848 x 848 pixels, modified Davis classification: 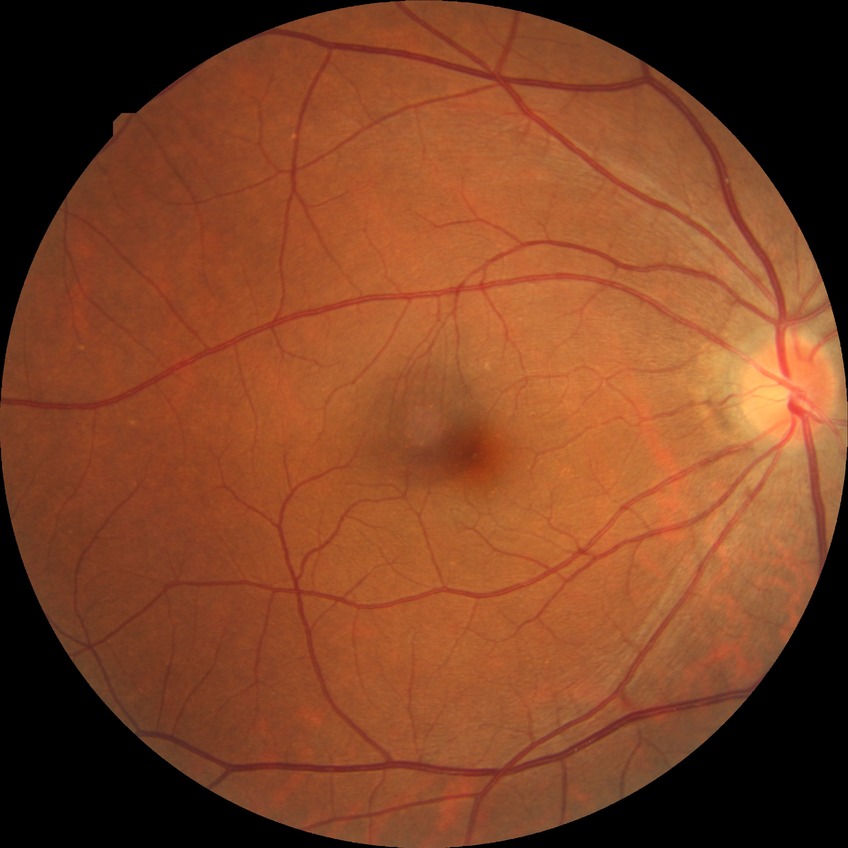 Retinopathy stage is no diabetic retinopathy.